848 by 848 pixels; 45° field of view; modified Davis classification — 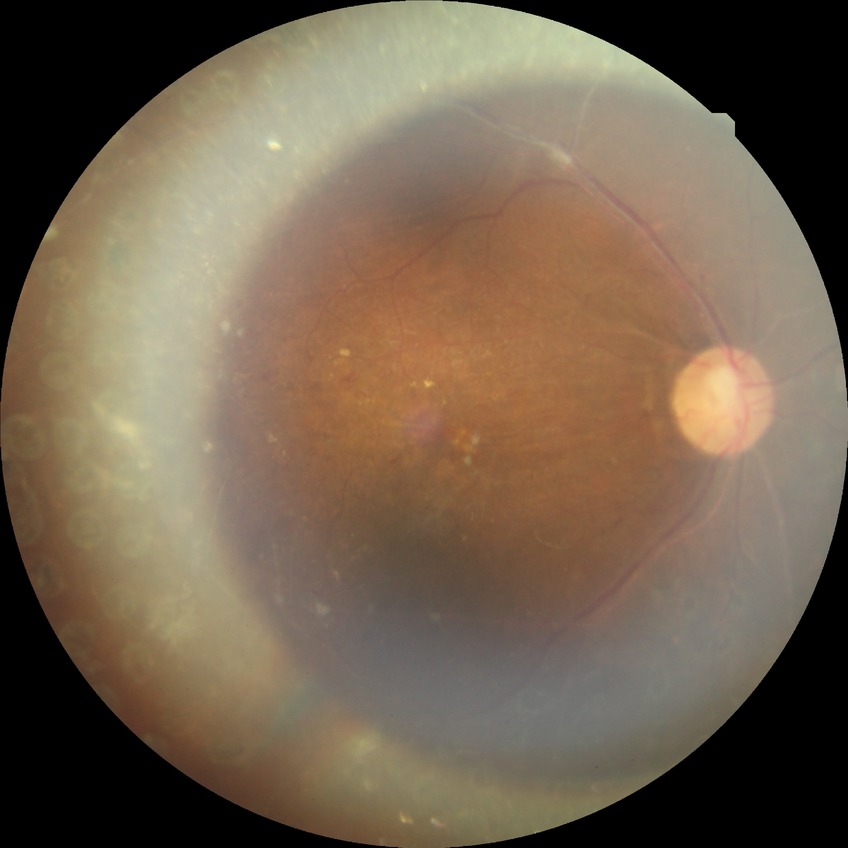
* modified Davis classification — proliferative diabetic retinopathy